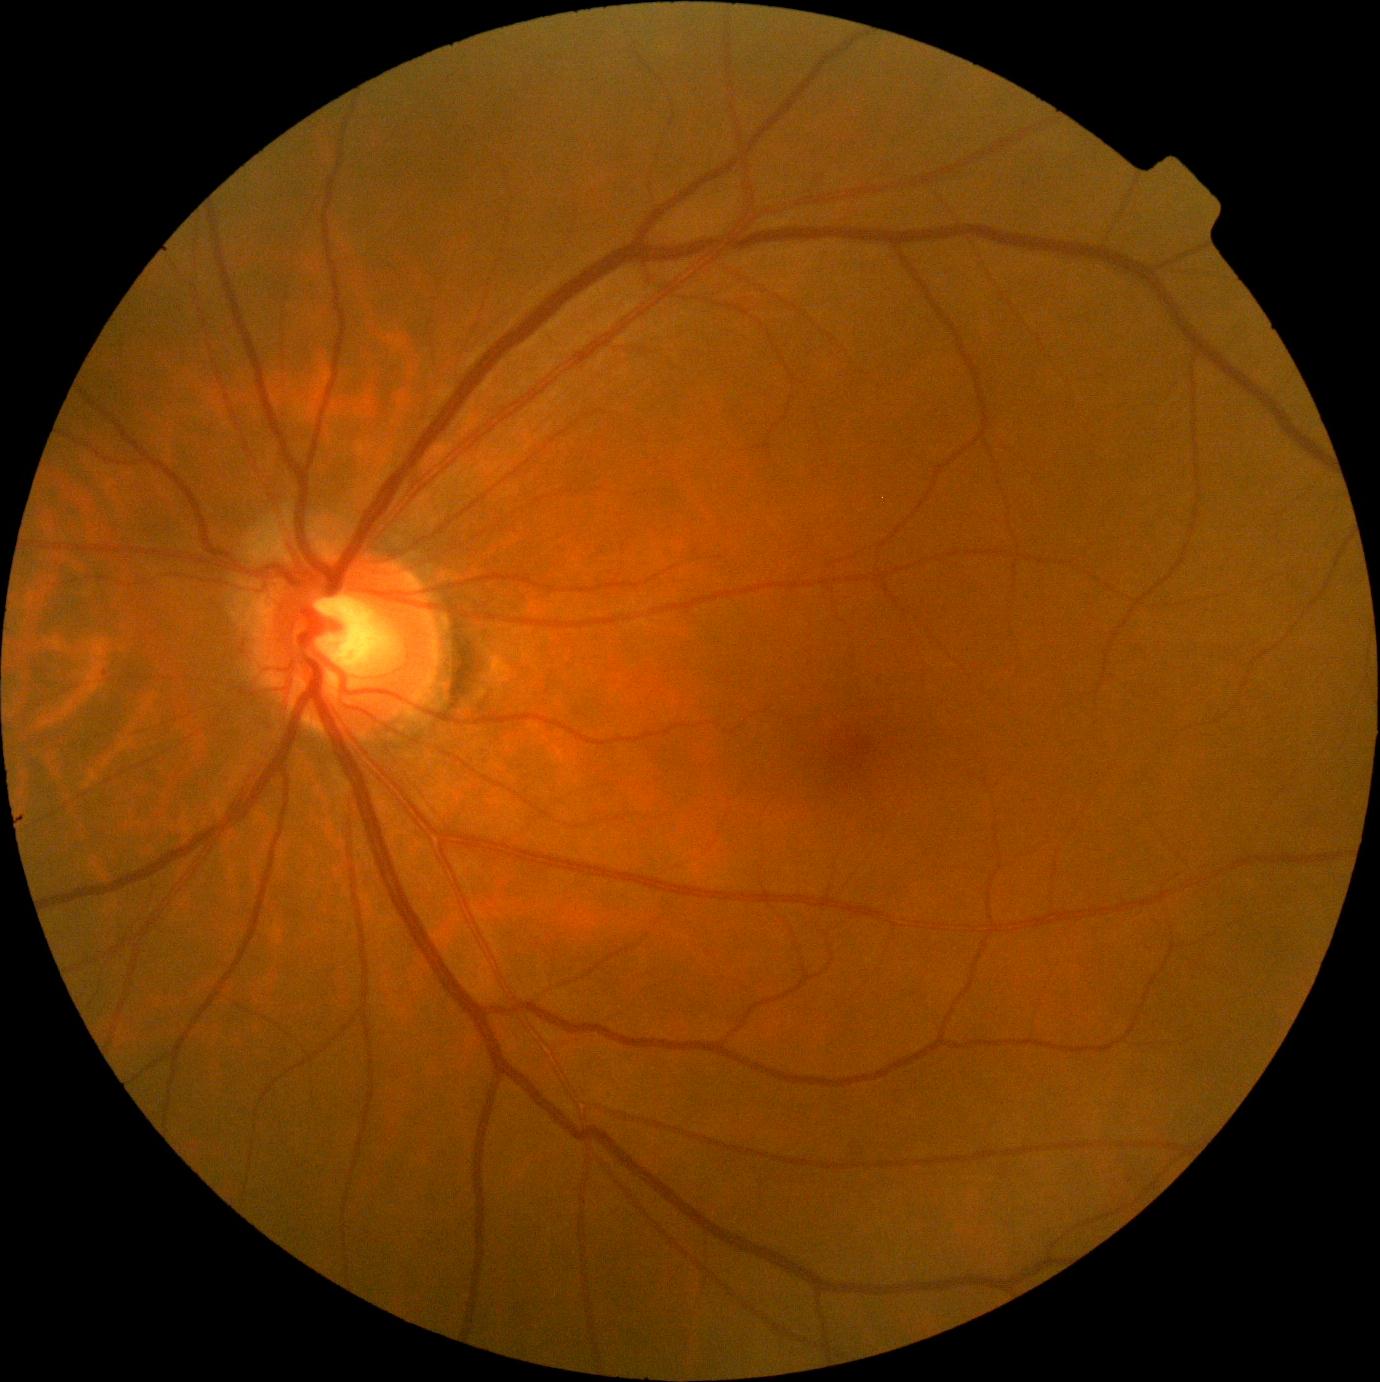

DR class: non-proliferative diabetic retinopathy
diabetic retinopathy: grade 1